Captured on a Remidio Fundus on Phone (FOP) camera; fundus photo.
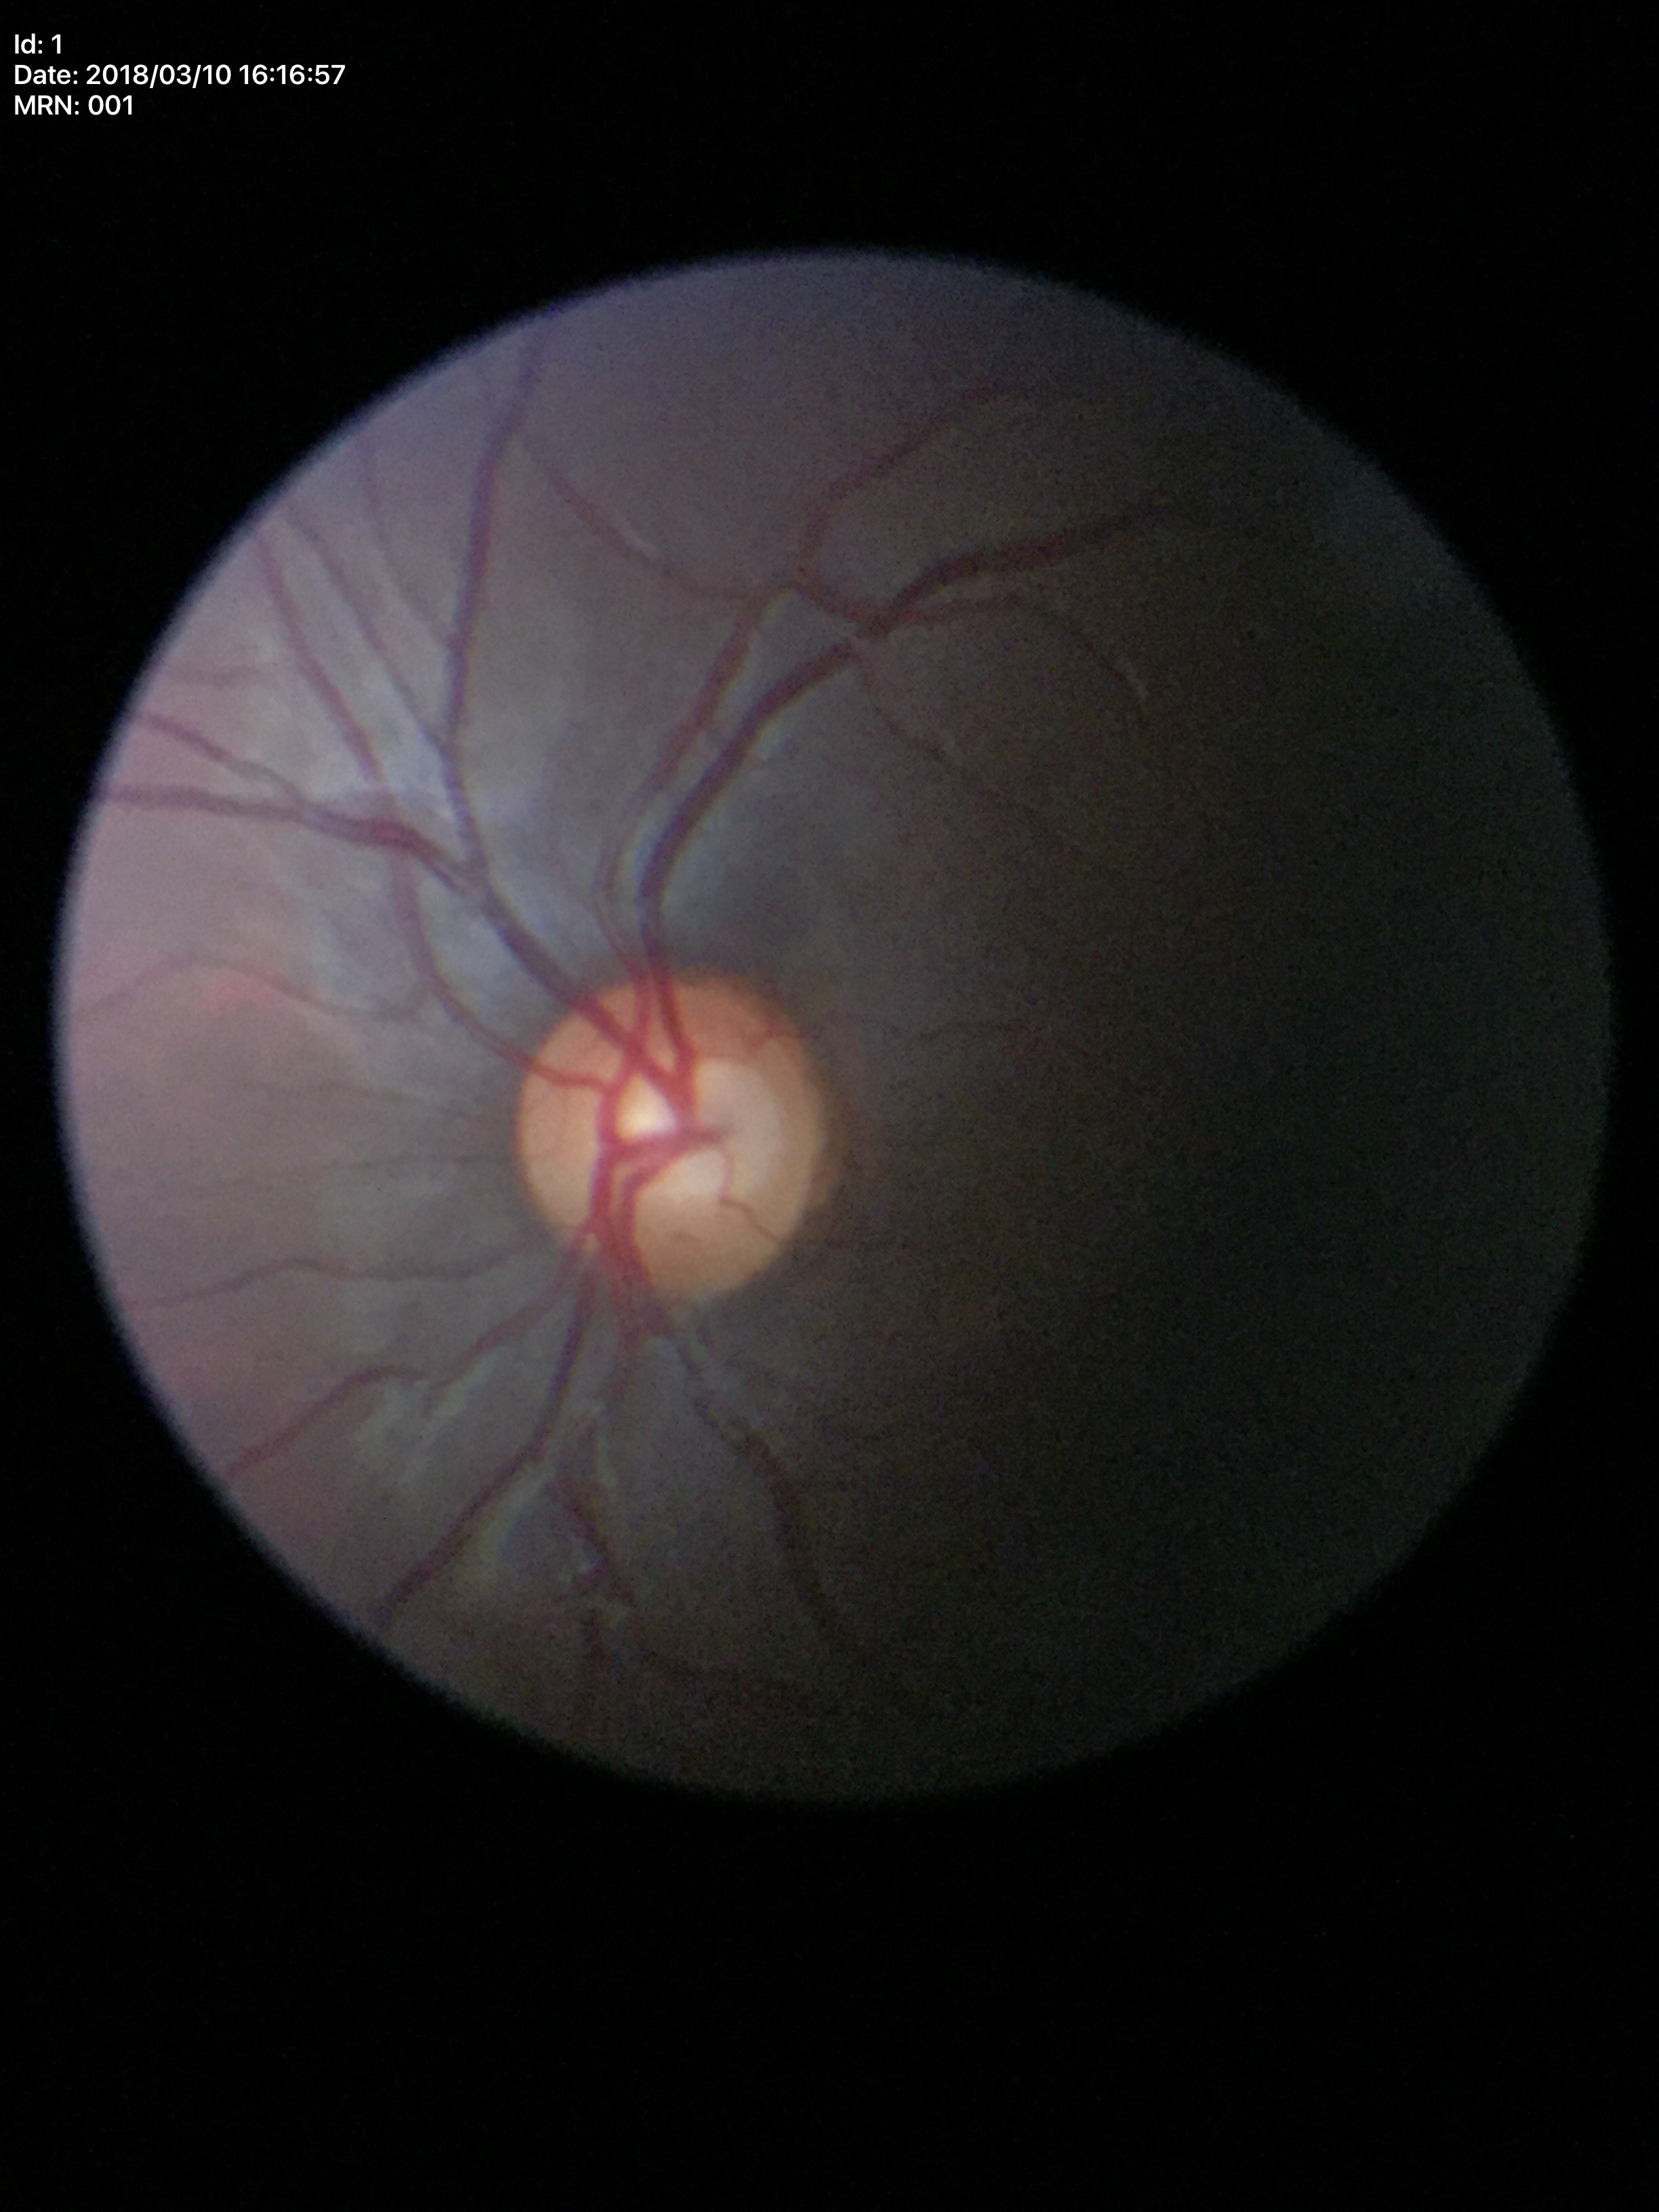 Glaucoma decision: no suspicious findings. VCDR is 0.60.